240x240; fundus photo:
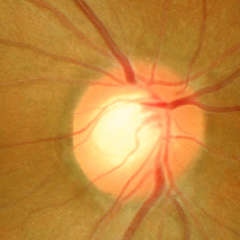 Q: Glaucoma assessment?
A: No glaucoma.